CFP, diabetic retinopathy graded by the modified Davis classification.
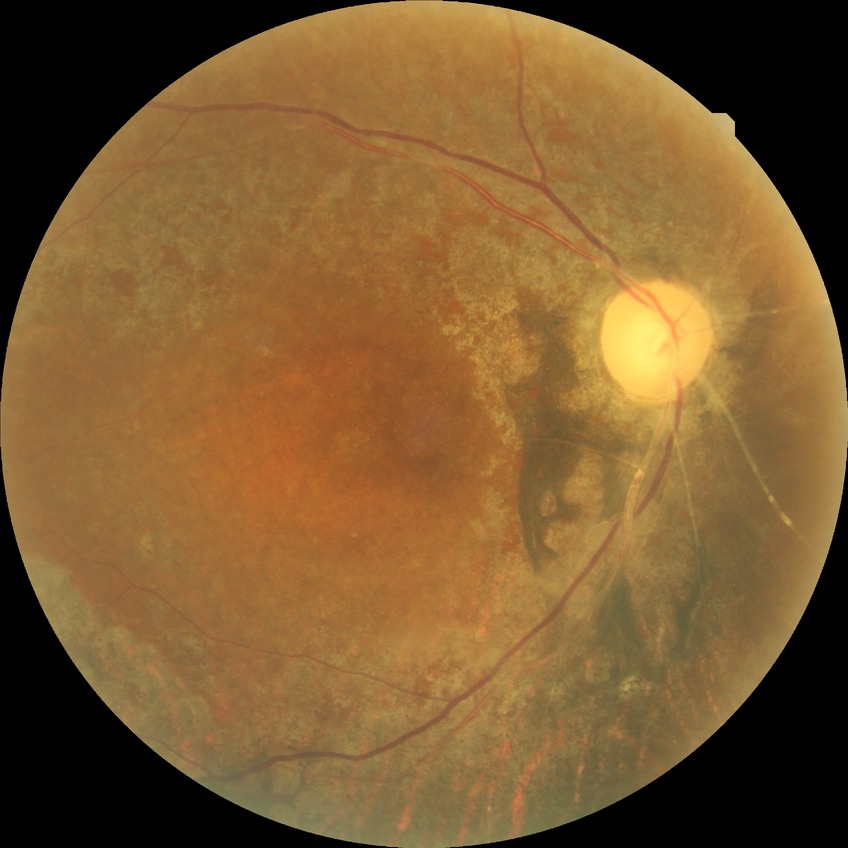
Diabetic retinopathy stage is simple diabetic retinopathy.